45° FOV: 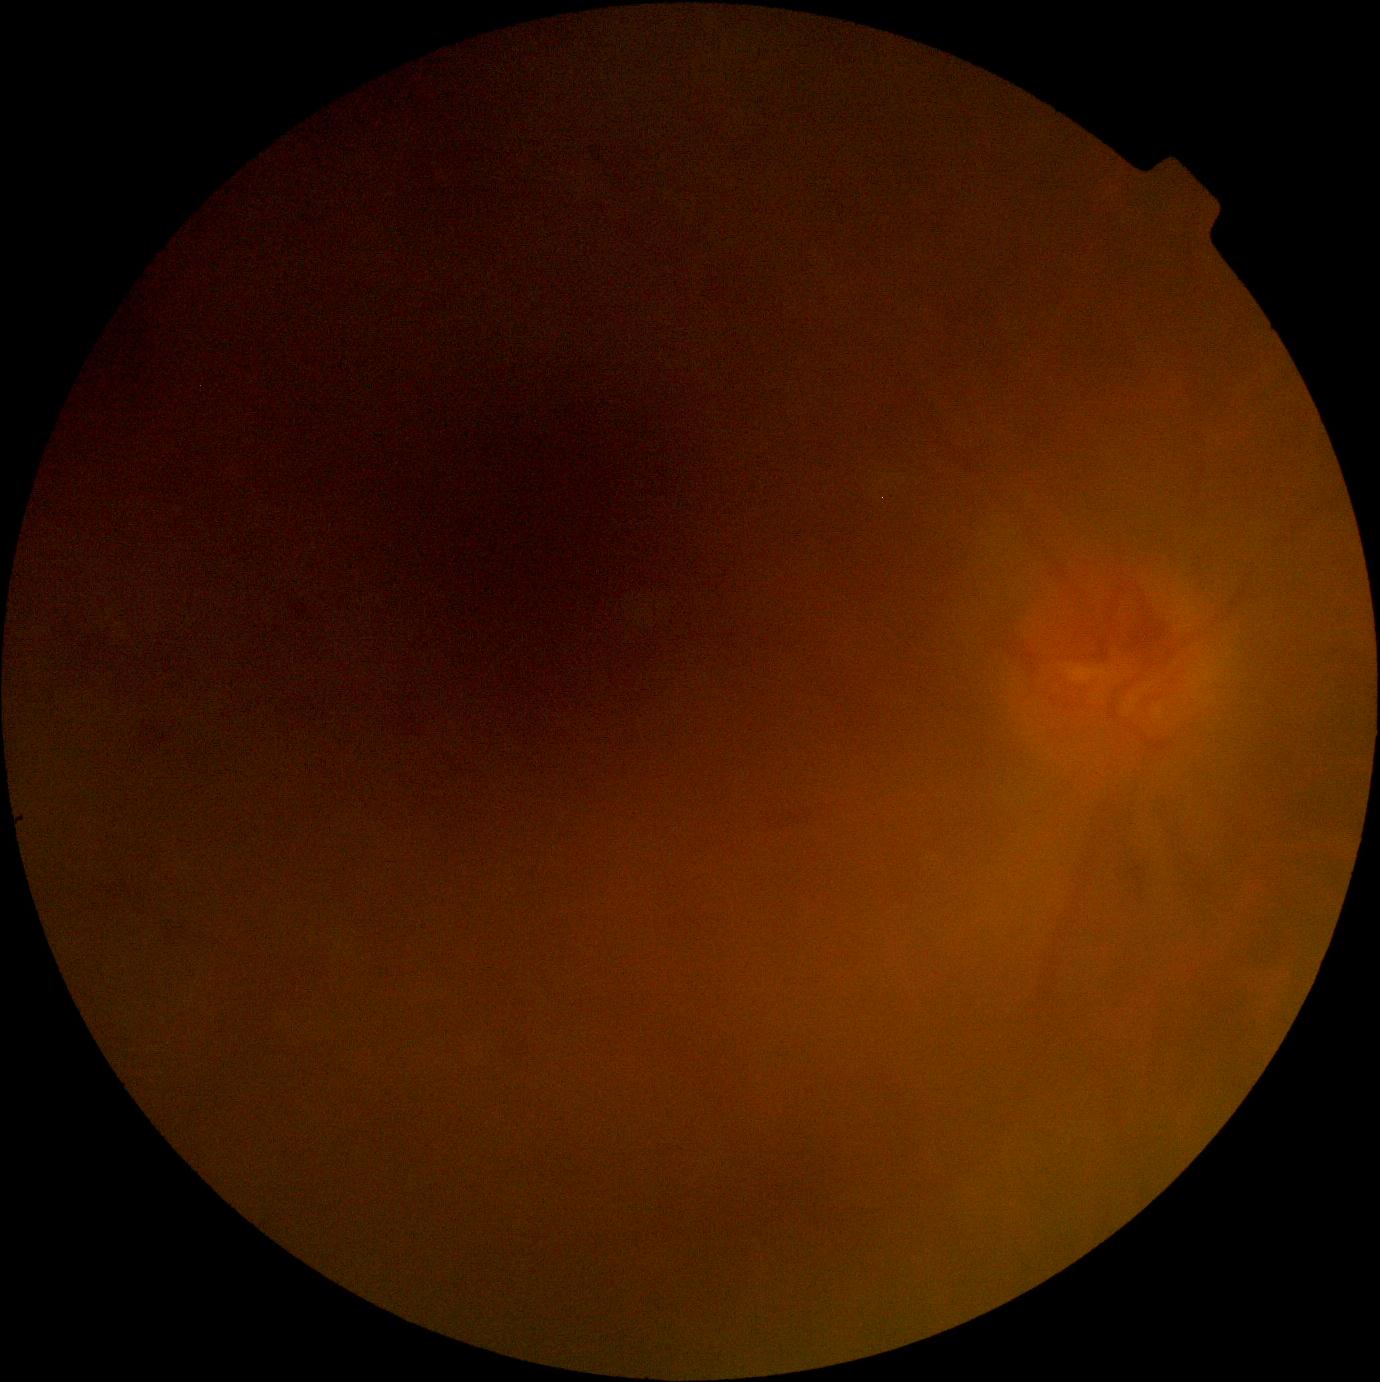

Diabetic retinopathy is ungradable.